848x848px: 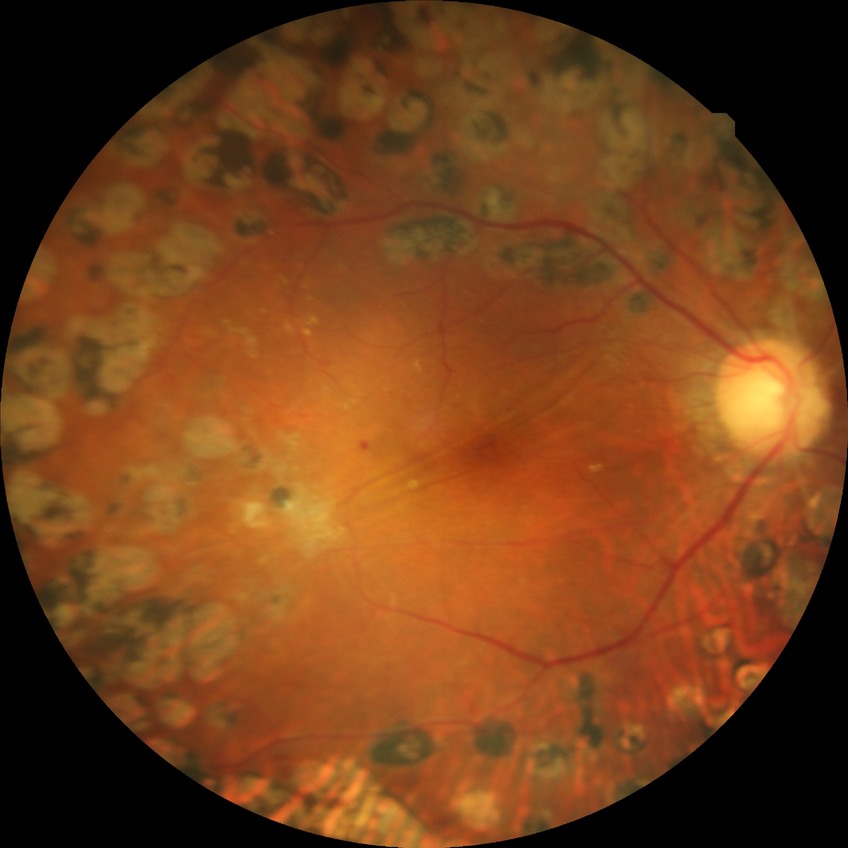
diabetic retinopathy (DR) = PDR (proliferative diabetic retinopathy).